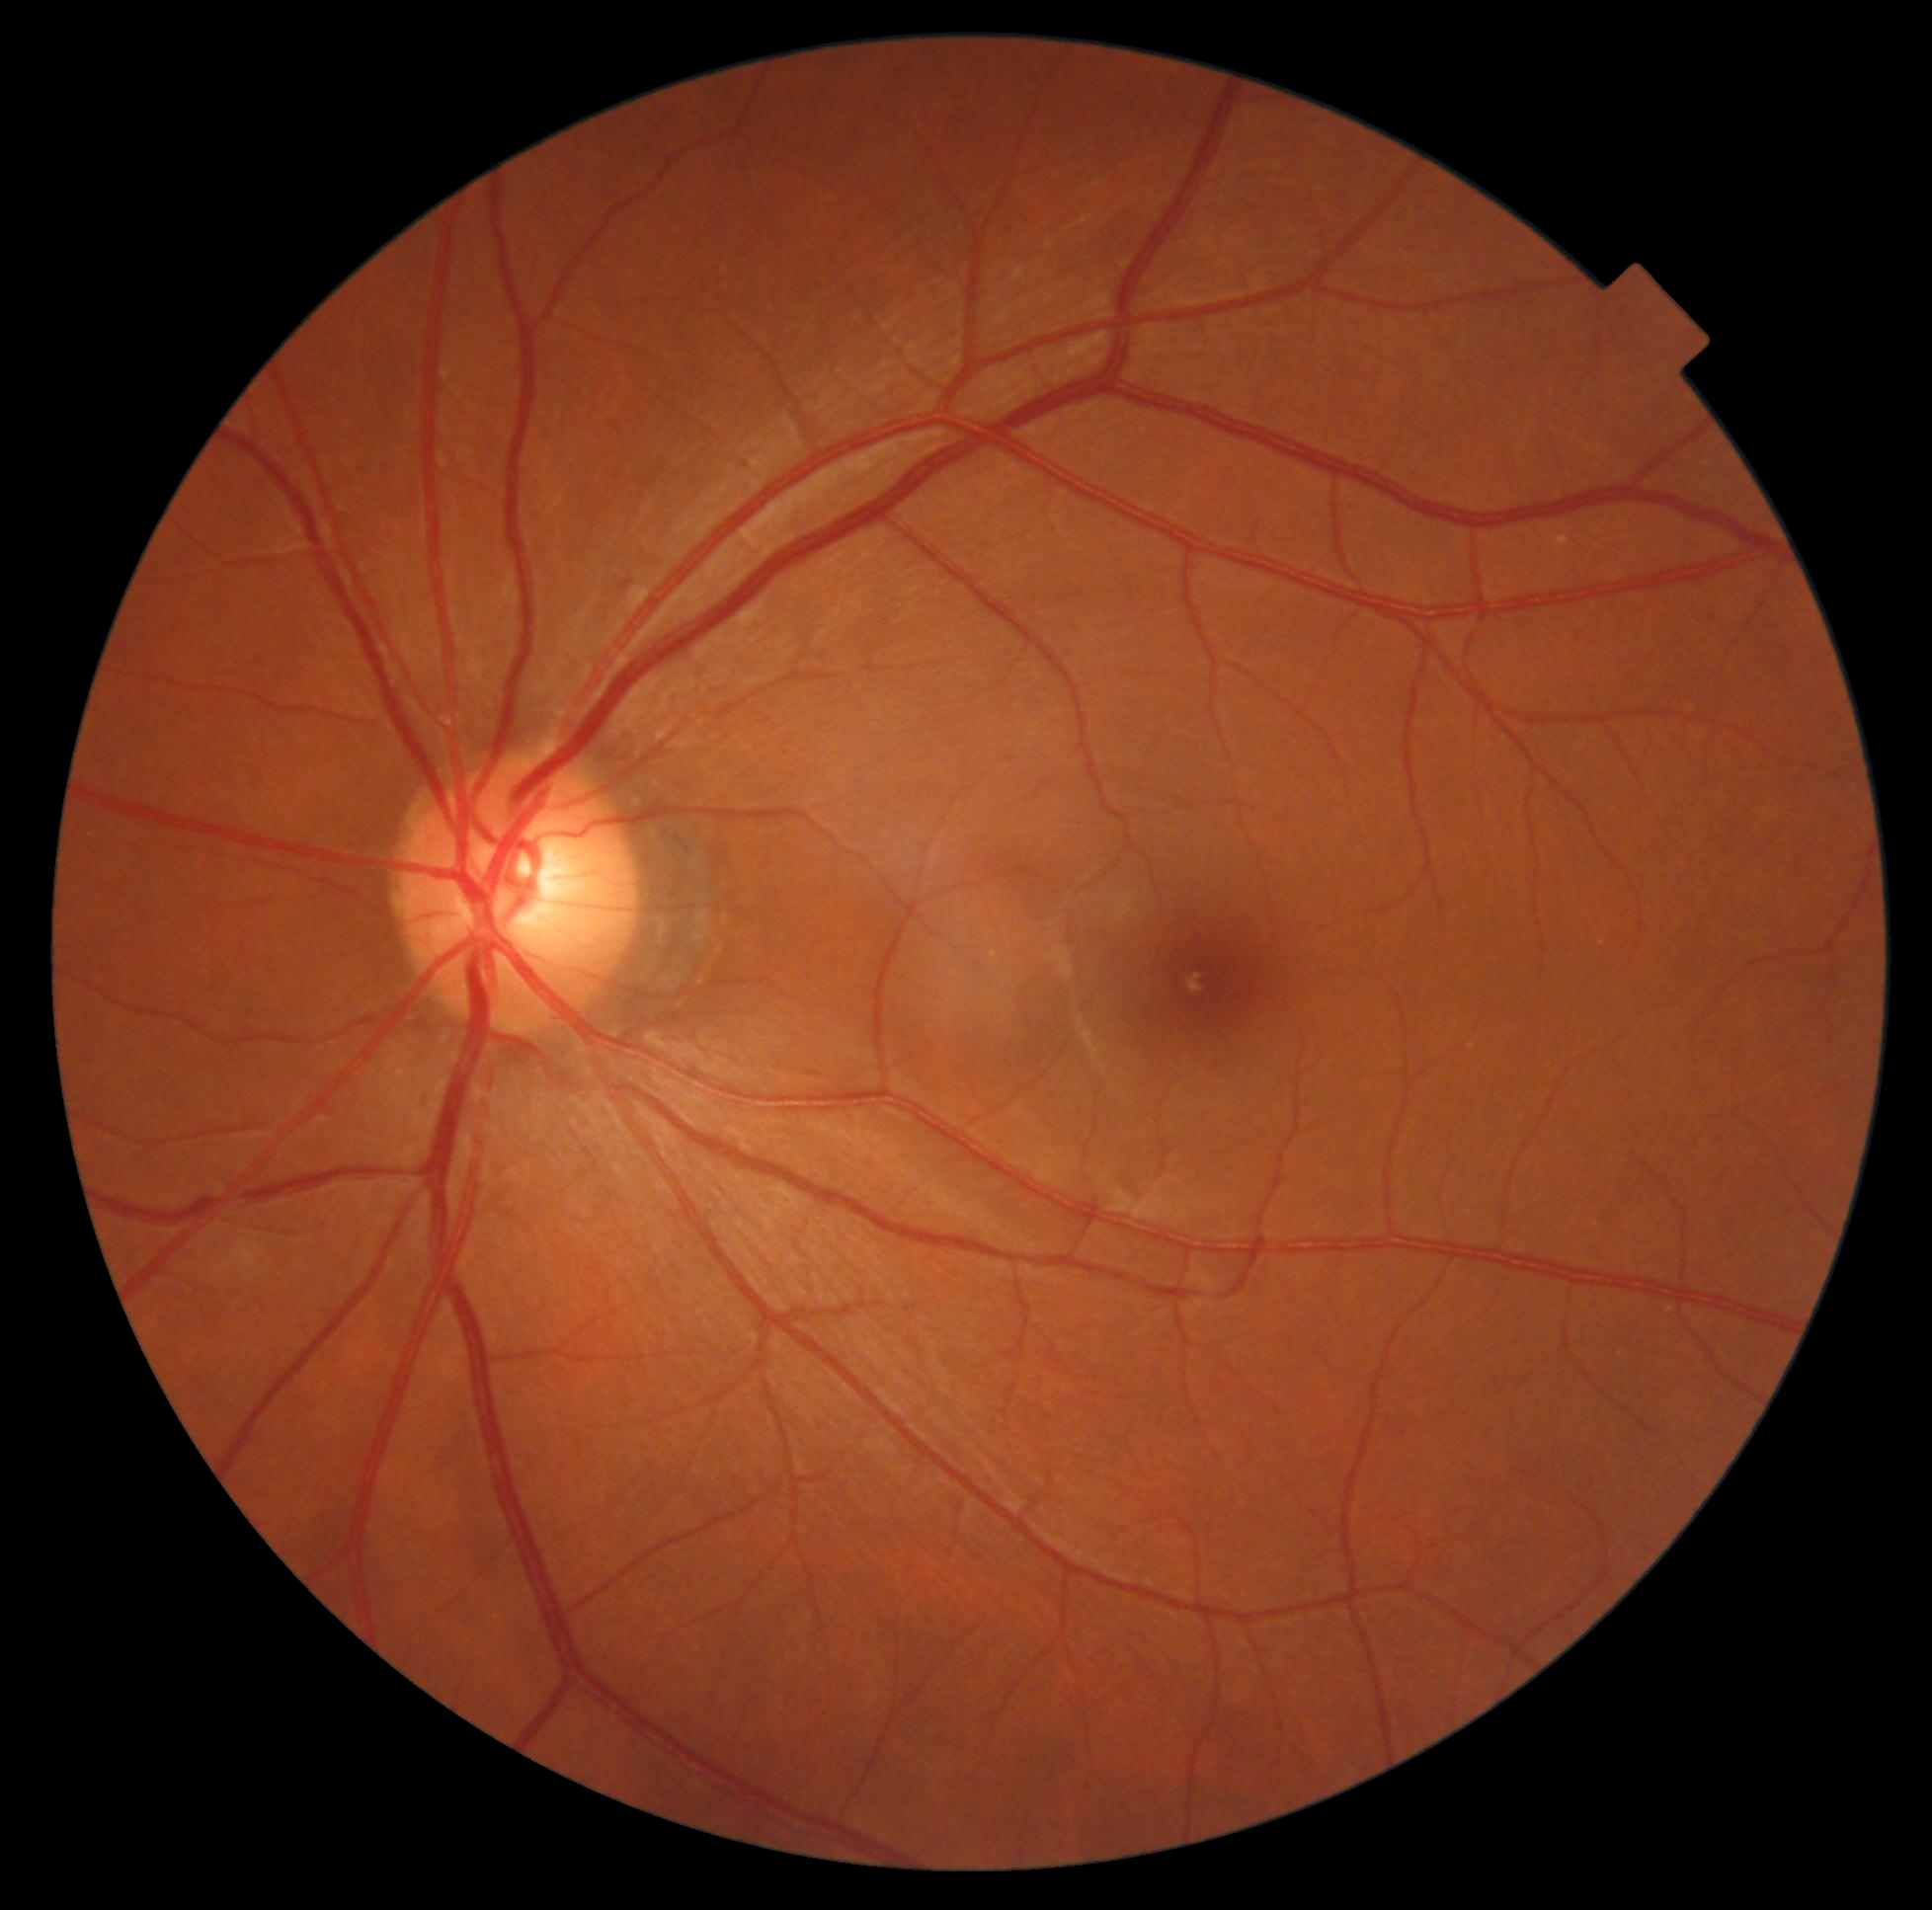 DR stage is no apparent retinopathy (grade 0).